Without pupil dilation. Diabetic retinopathy graded by the modified Davis classification. Acquired with a NIDEK AFC-230. Image size 848x848: 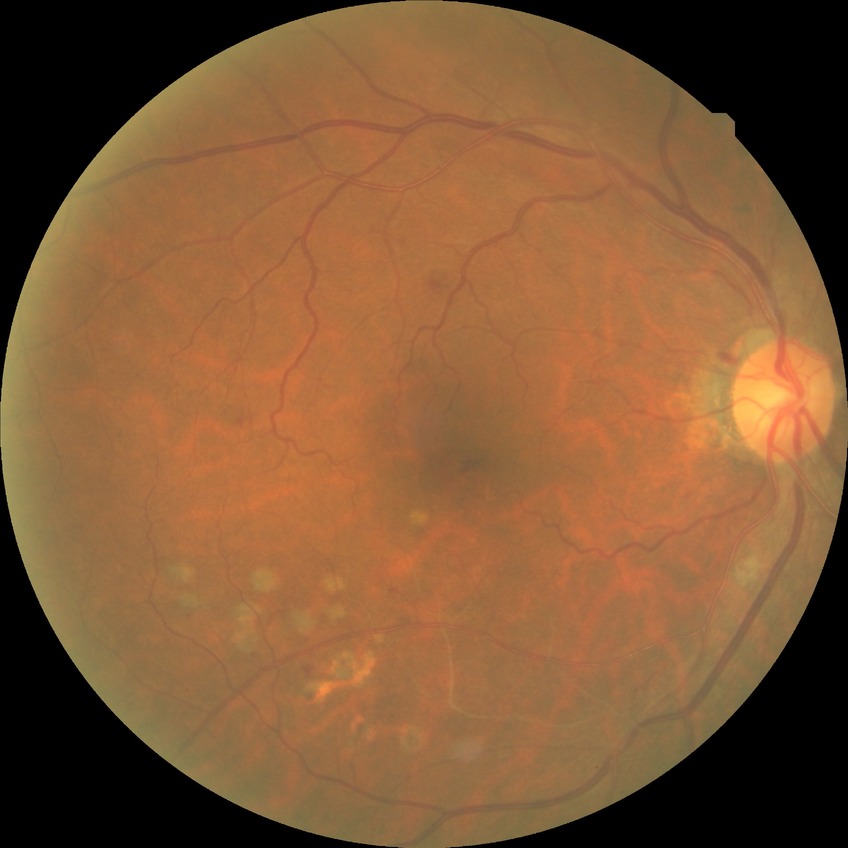 Diabetic retinopathy (DR): SDR (simple diabetic retinopathy).